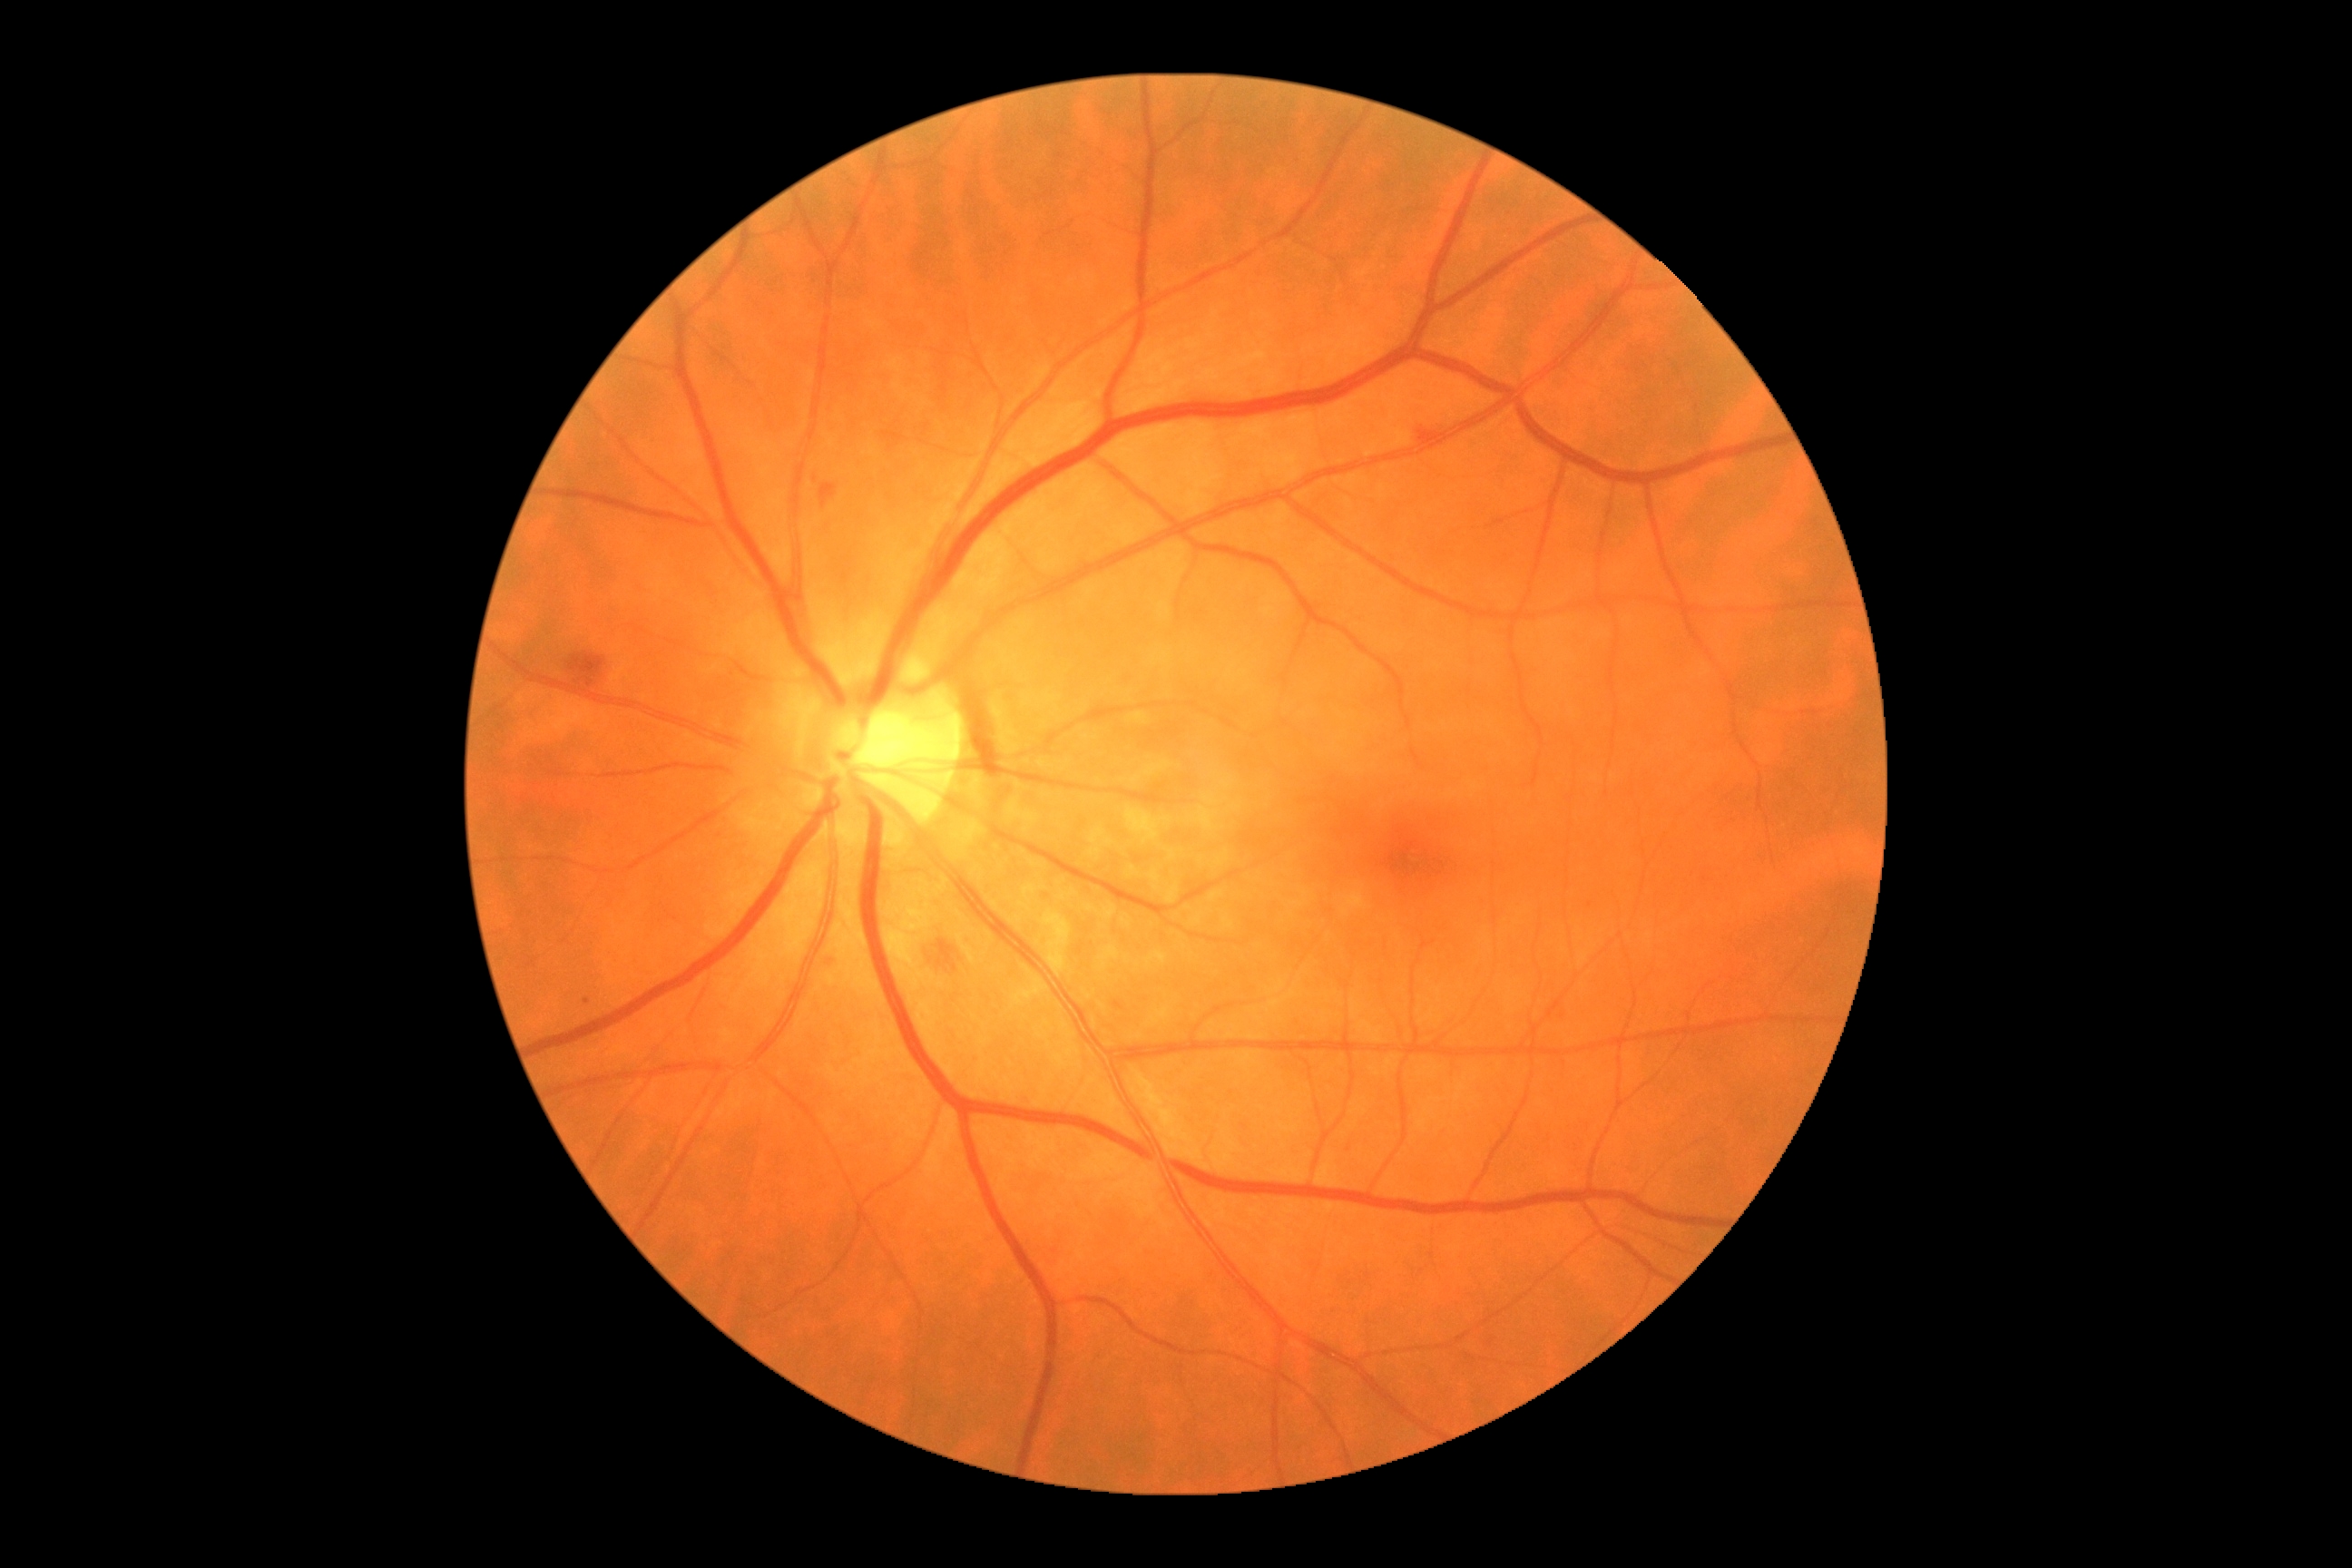
Diabetic retinopathy (DR): 2/4.